45-degree field of view · 2212 x 1659 pixels · CFP — 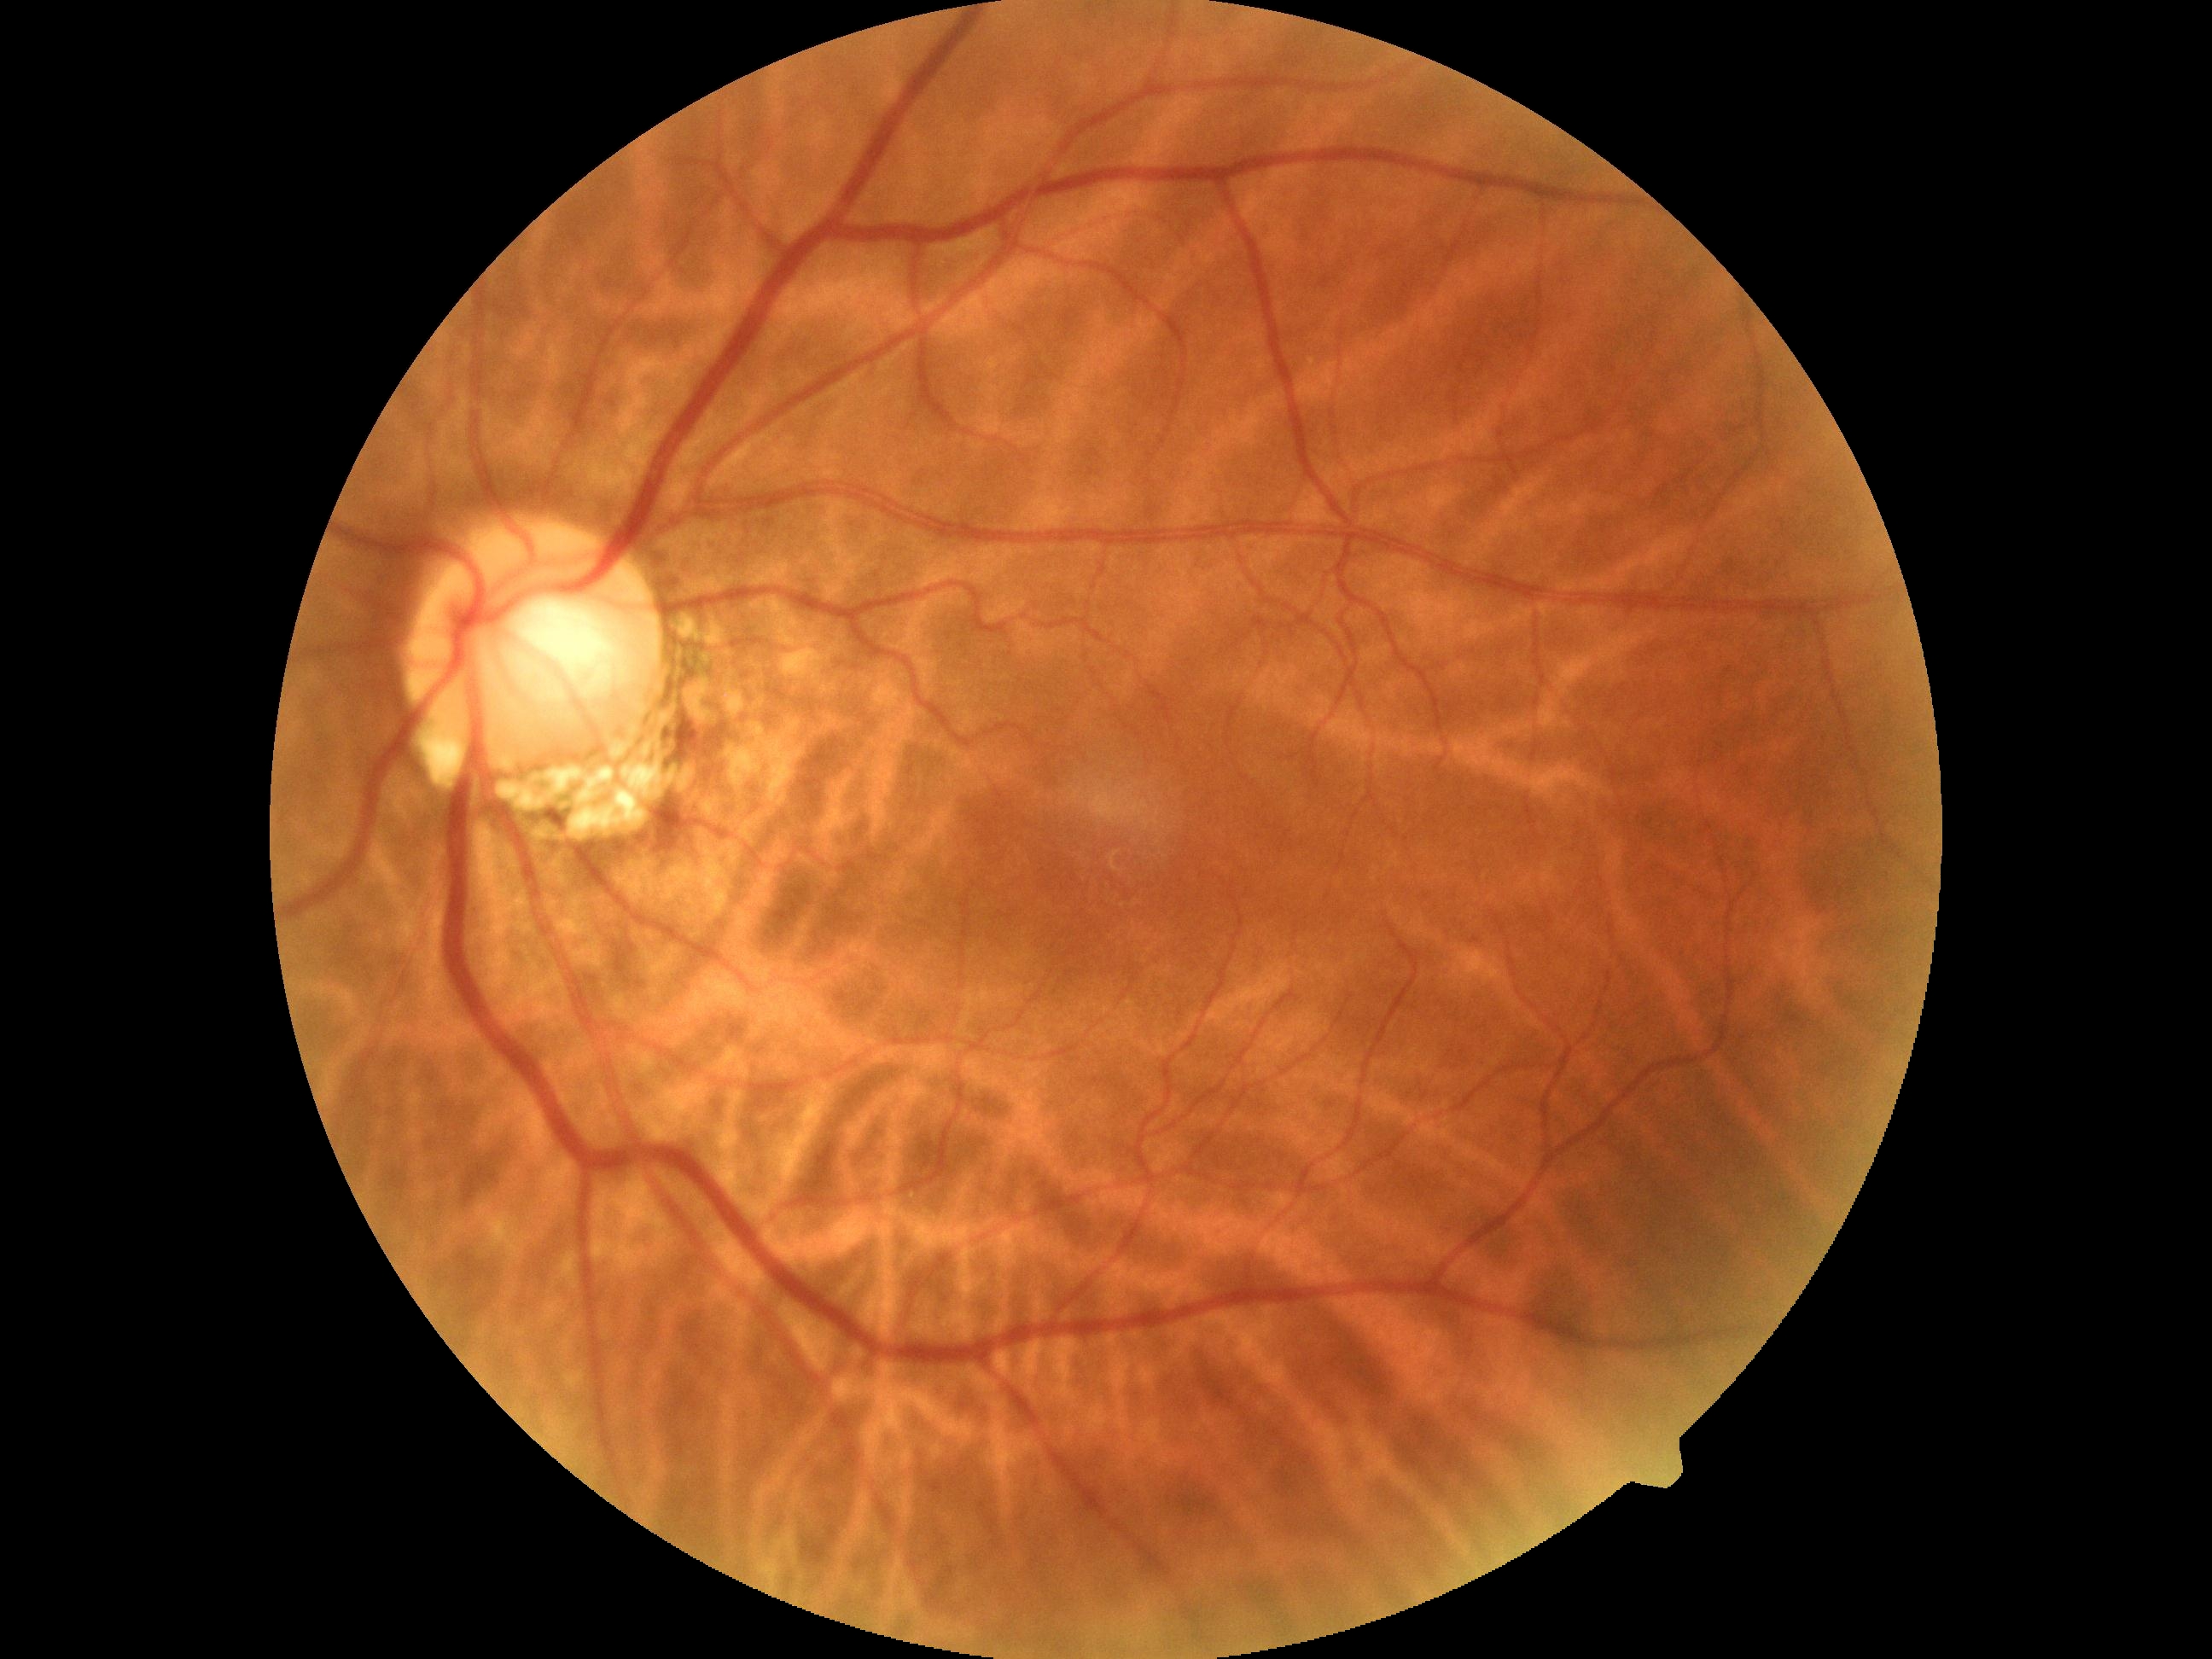
{"dr_grade": "0"}